Wide-field fundus photograph from neonatal ROP screening — 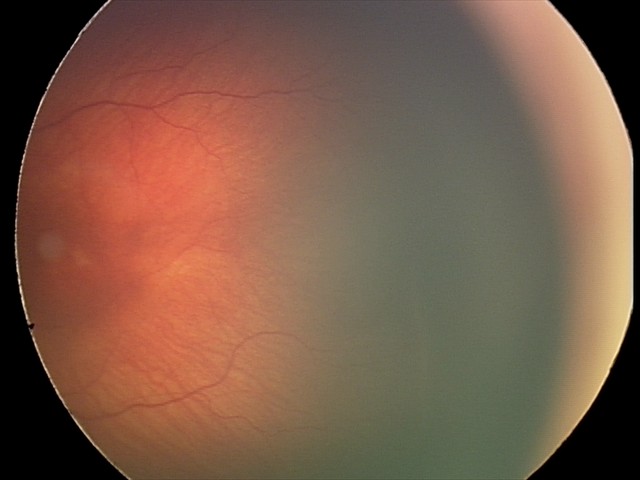
Impression = retinopathy of prematurity stage 2; plus form = absent — posterior pole vessels without abnormal dilation or tortuosity.